848 x 848 pixels, DR severity per modified Davis staging, camera: NIDEK AFC-230: 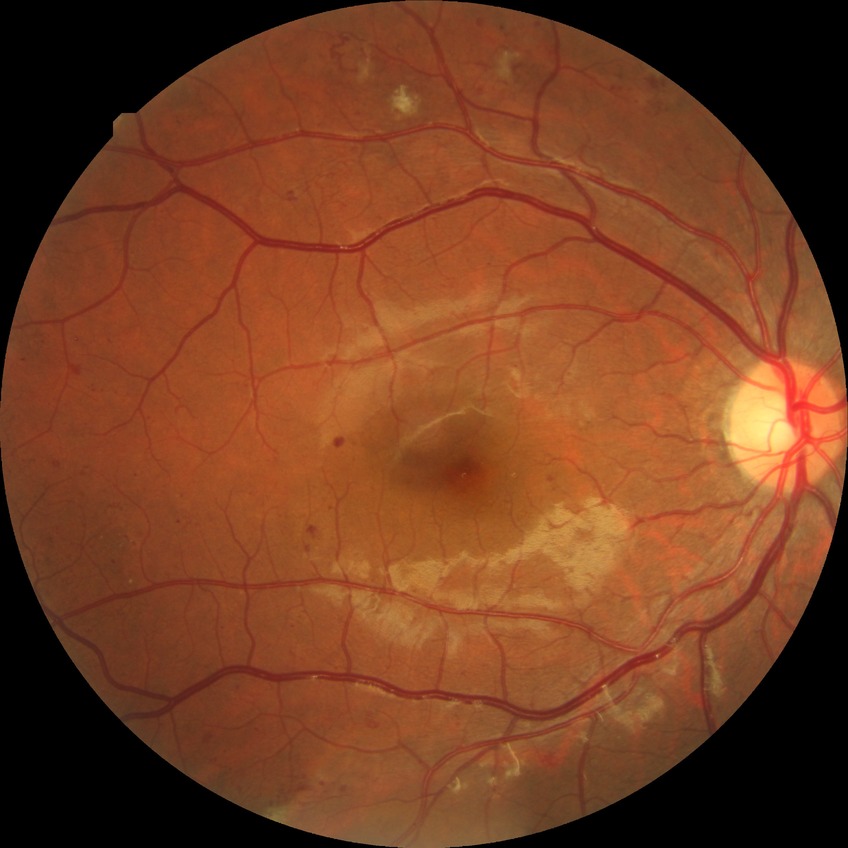

Davis stage: PPDR.